NIDEK AFC-230: 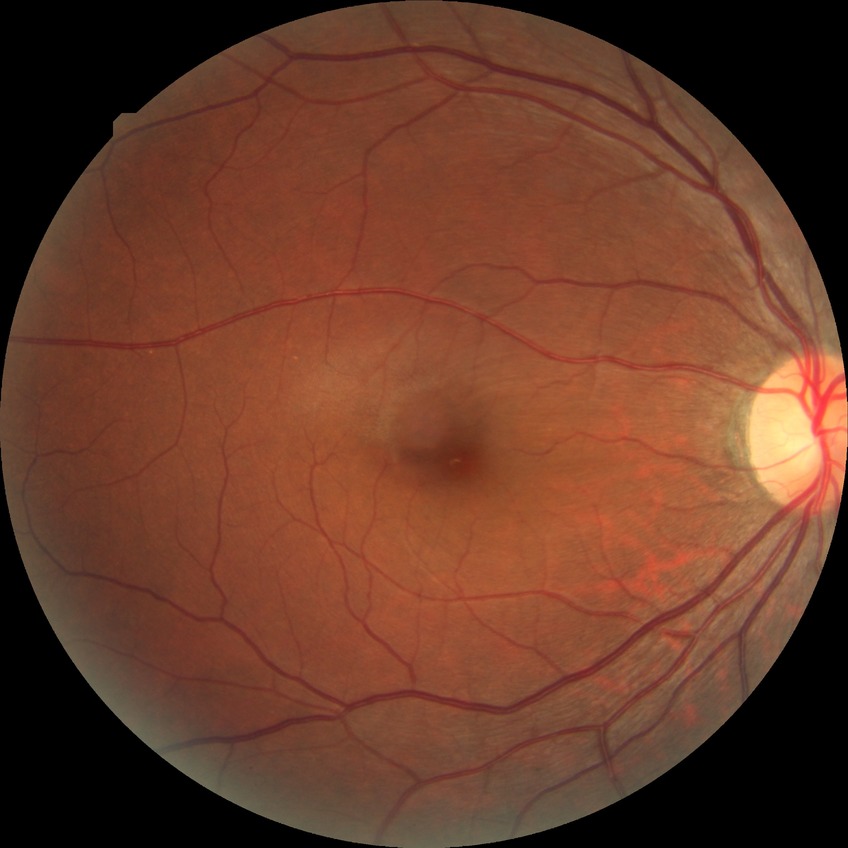
davis_grade: NDR (no diabetic retinopathy)